Sex: M
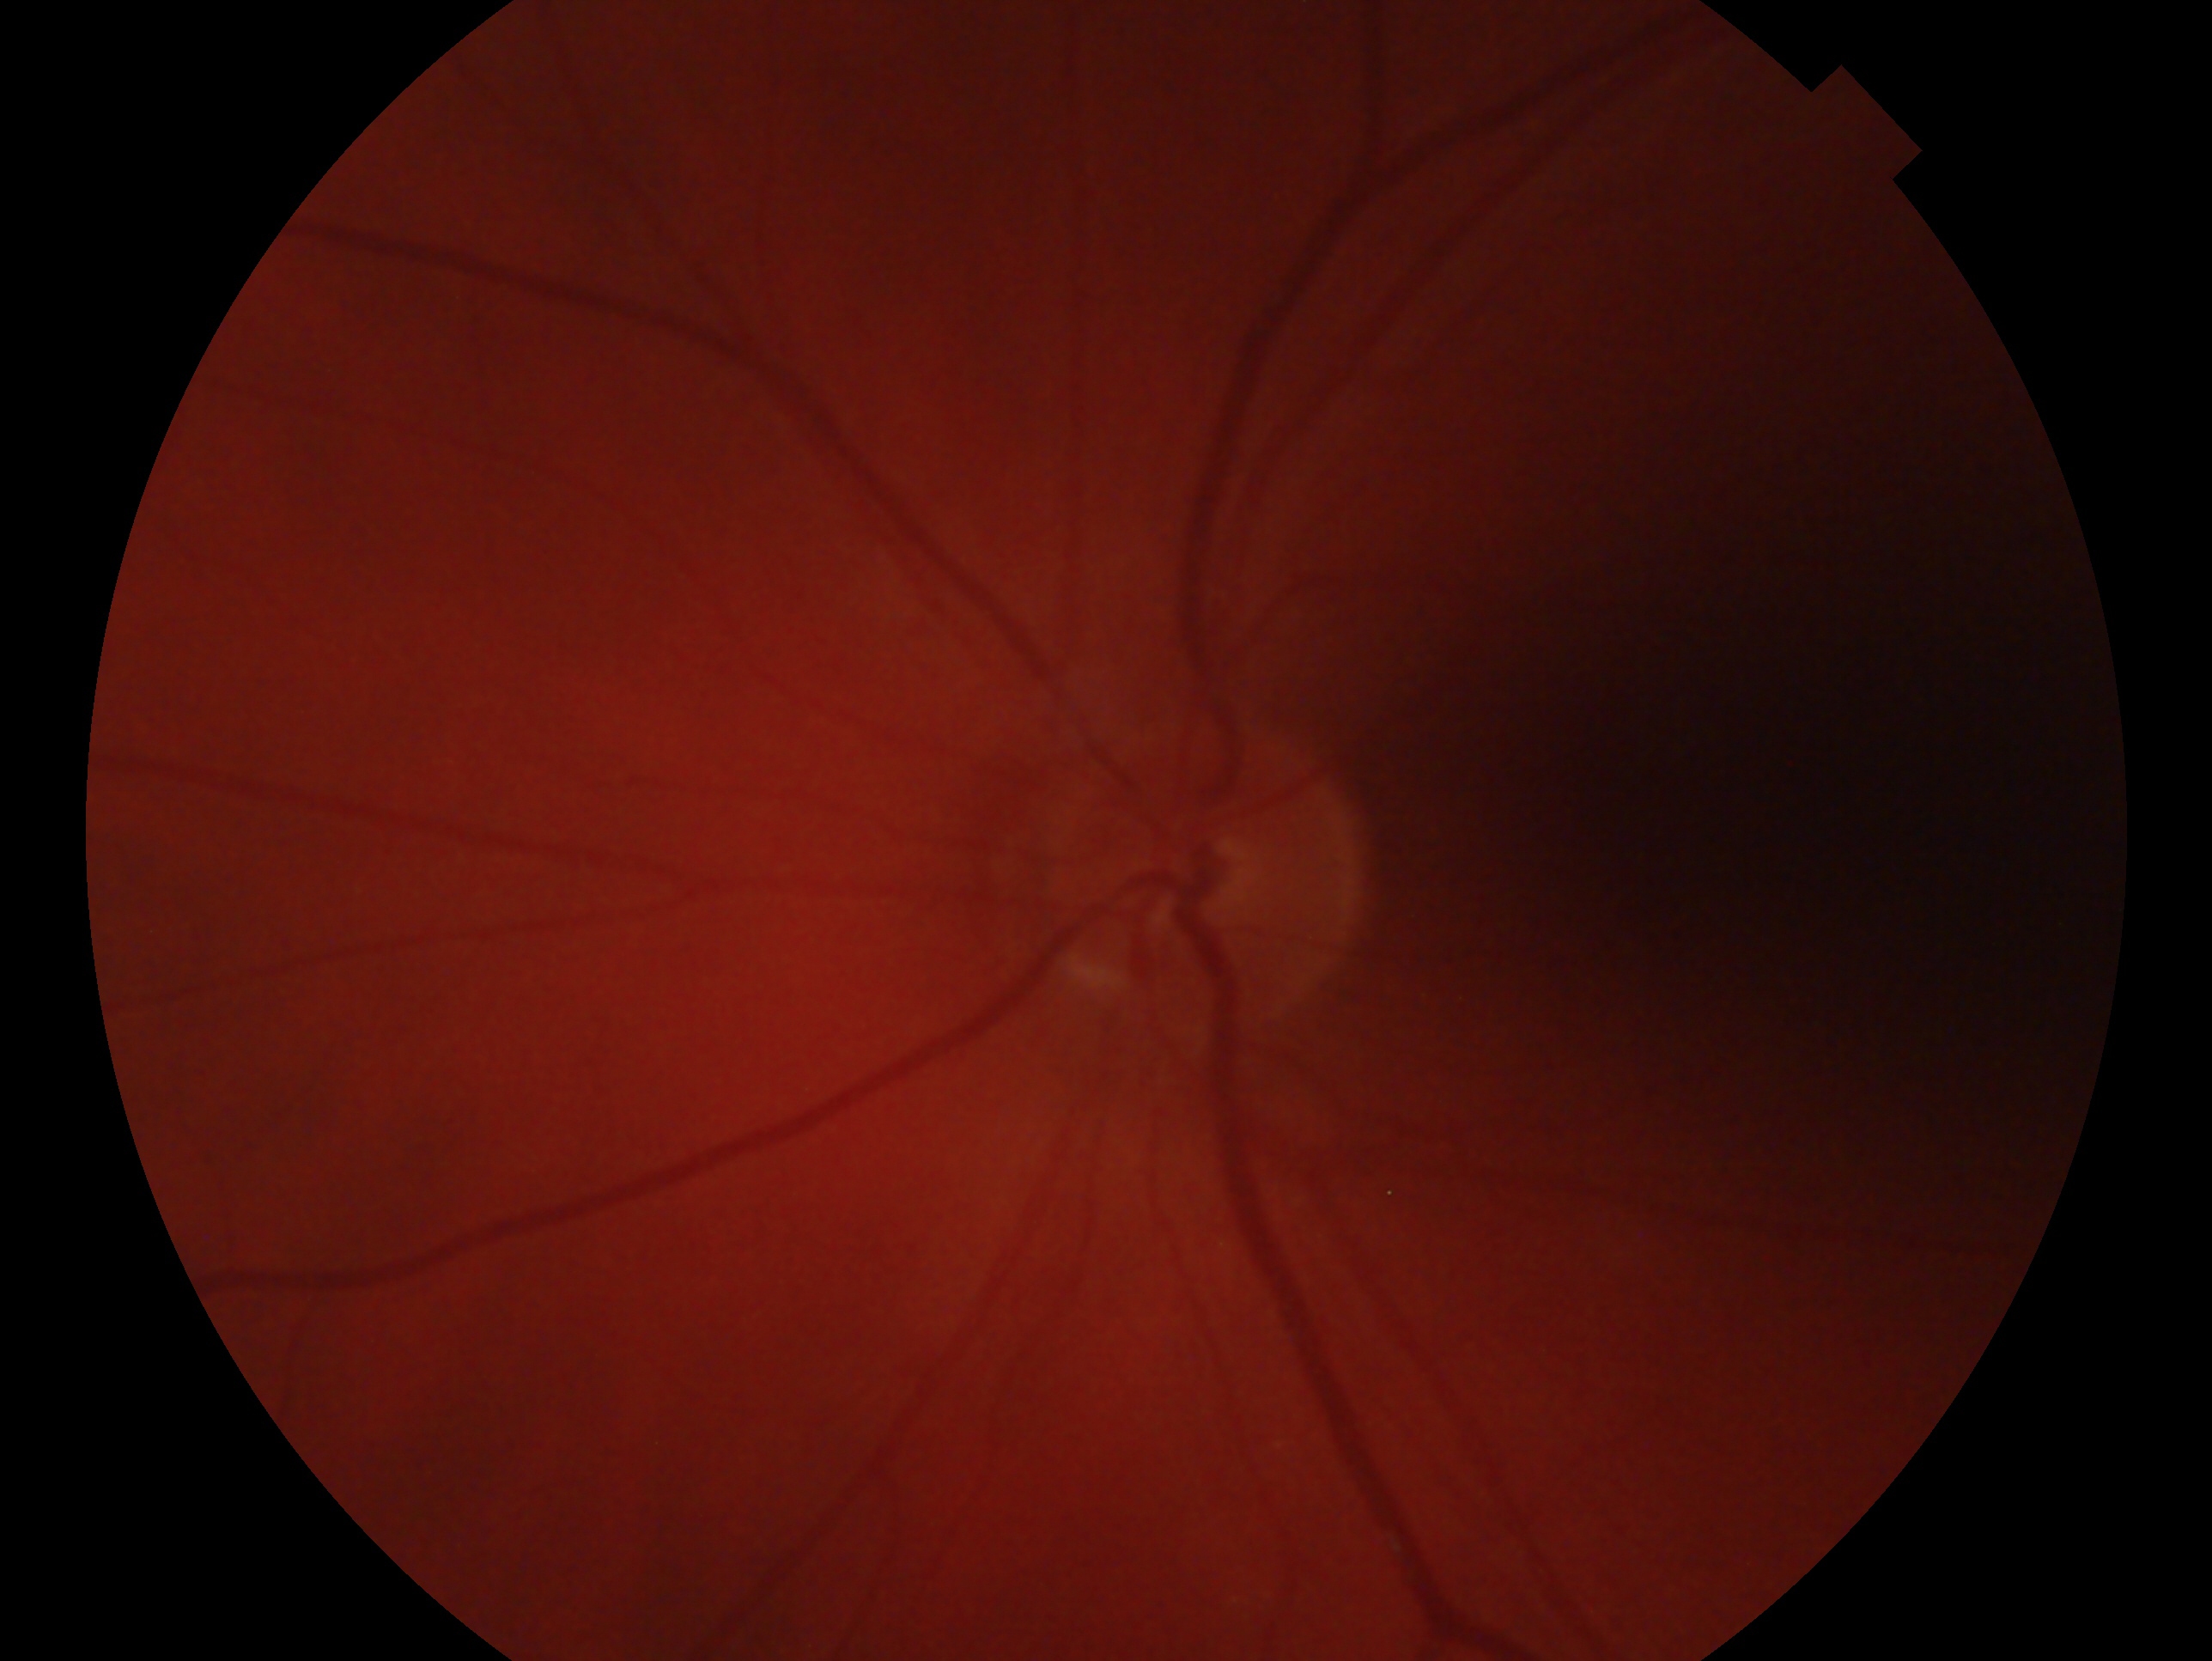

Diagnosis: no evidence of glaucoma. This is the OS.